Phoenix ICON wide-field infant fundus image.
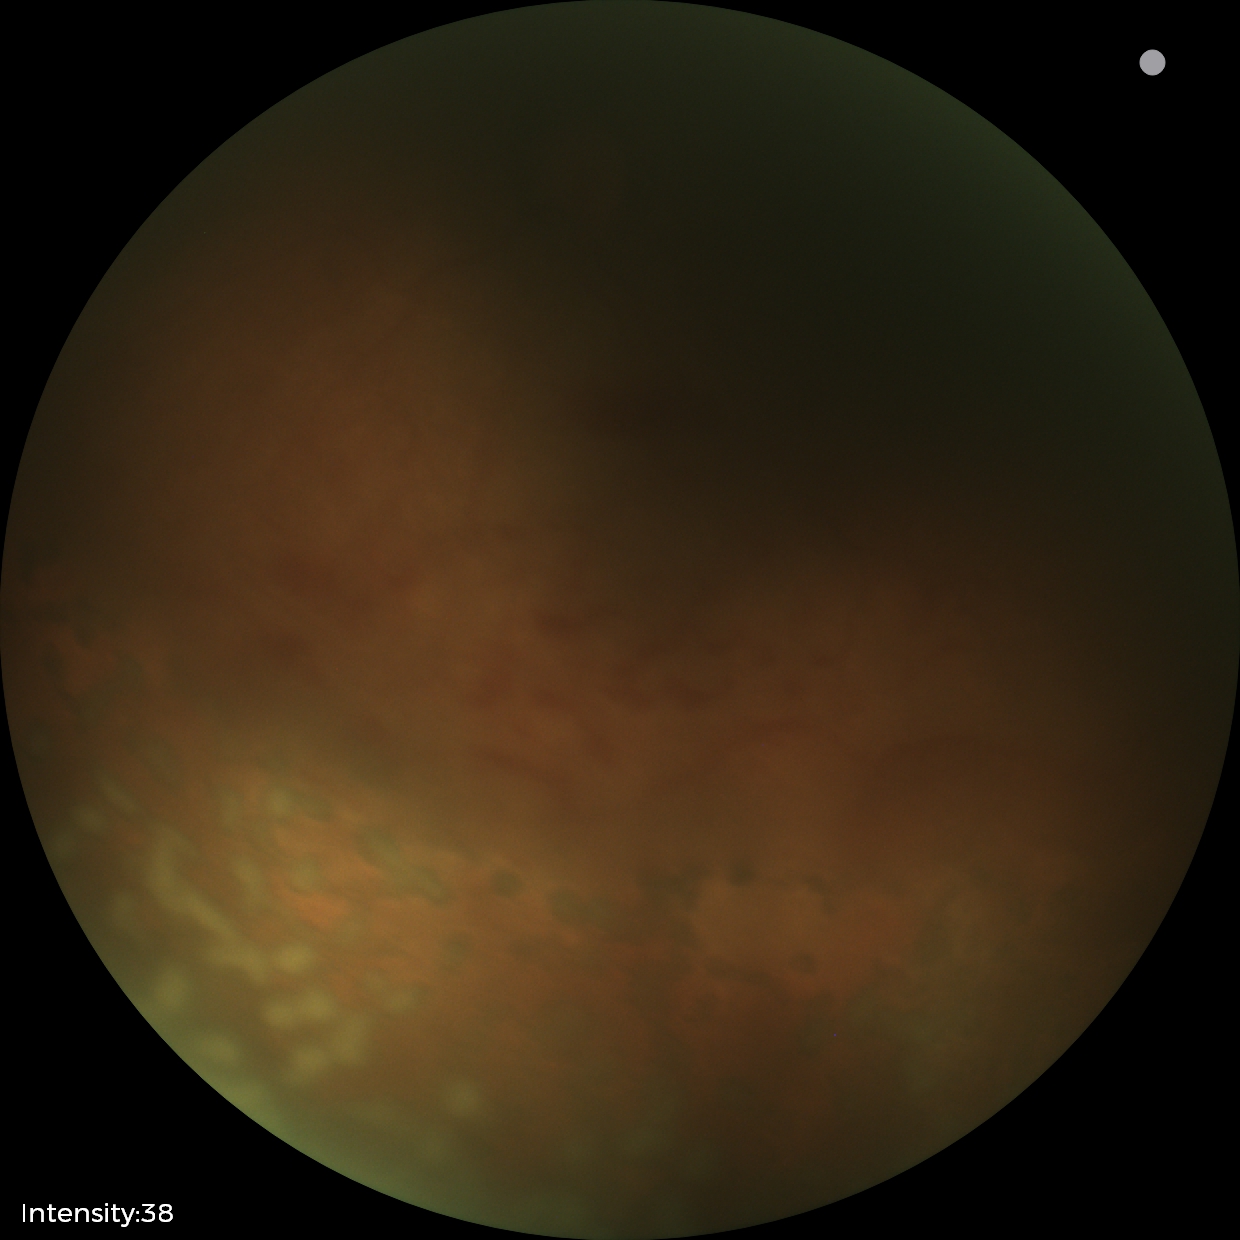
From an examination with diagnosis of status post ROP. Without plus disease.